Disc-centered fundus crop
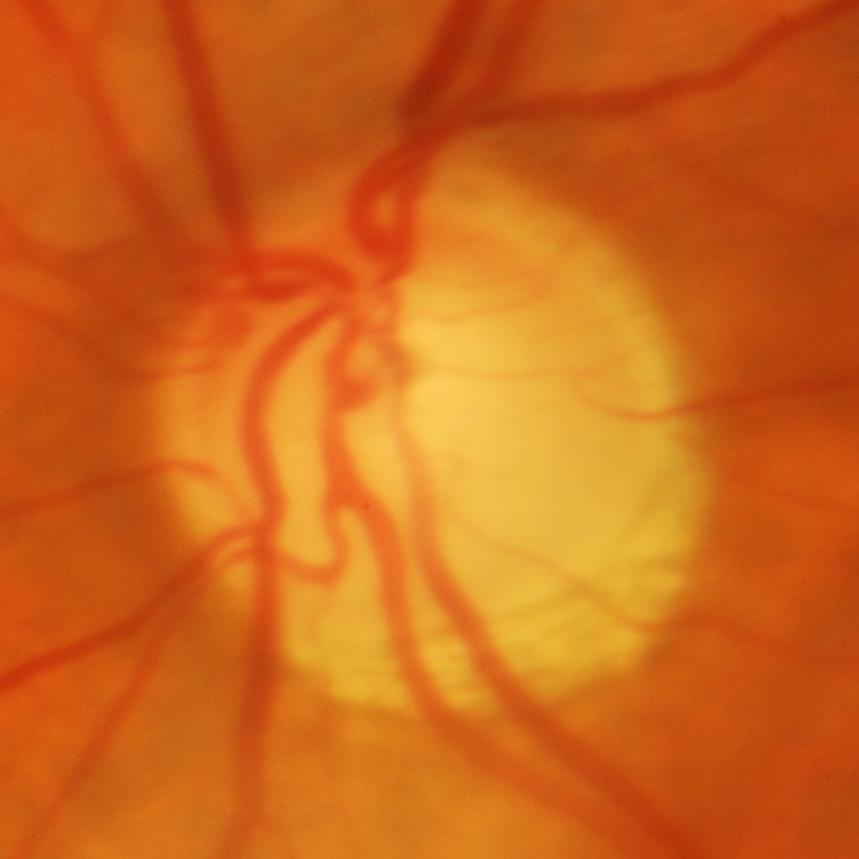

Showing glaucoma.